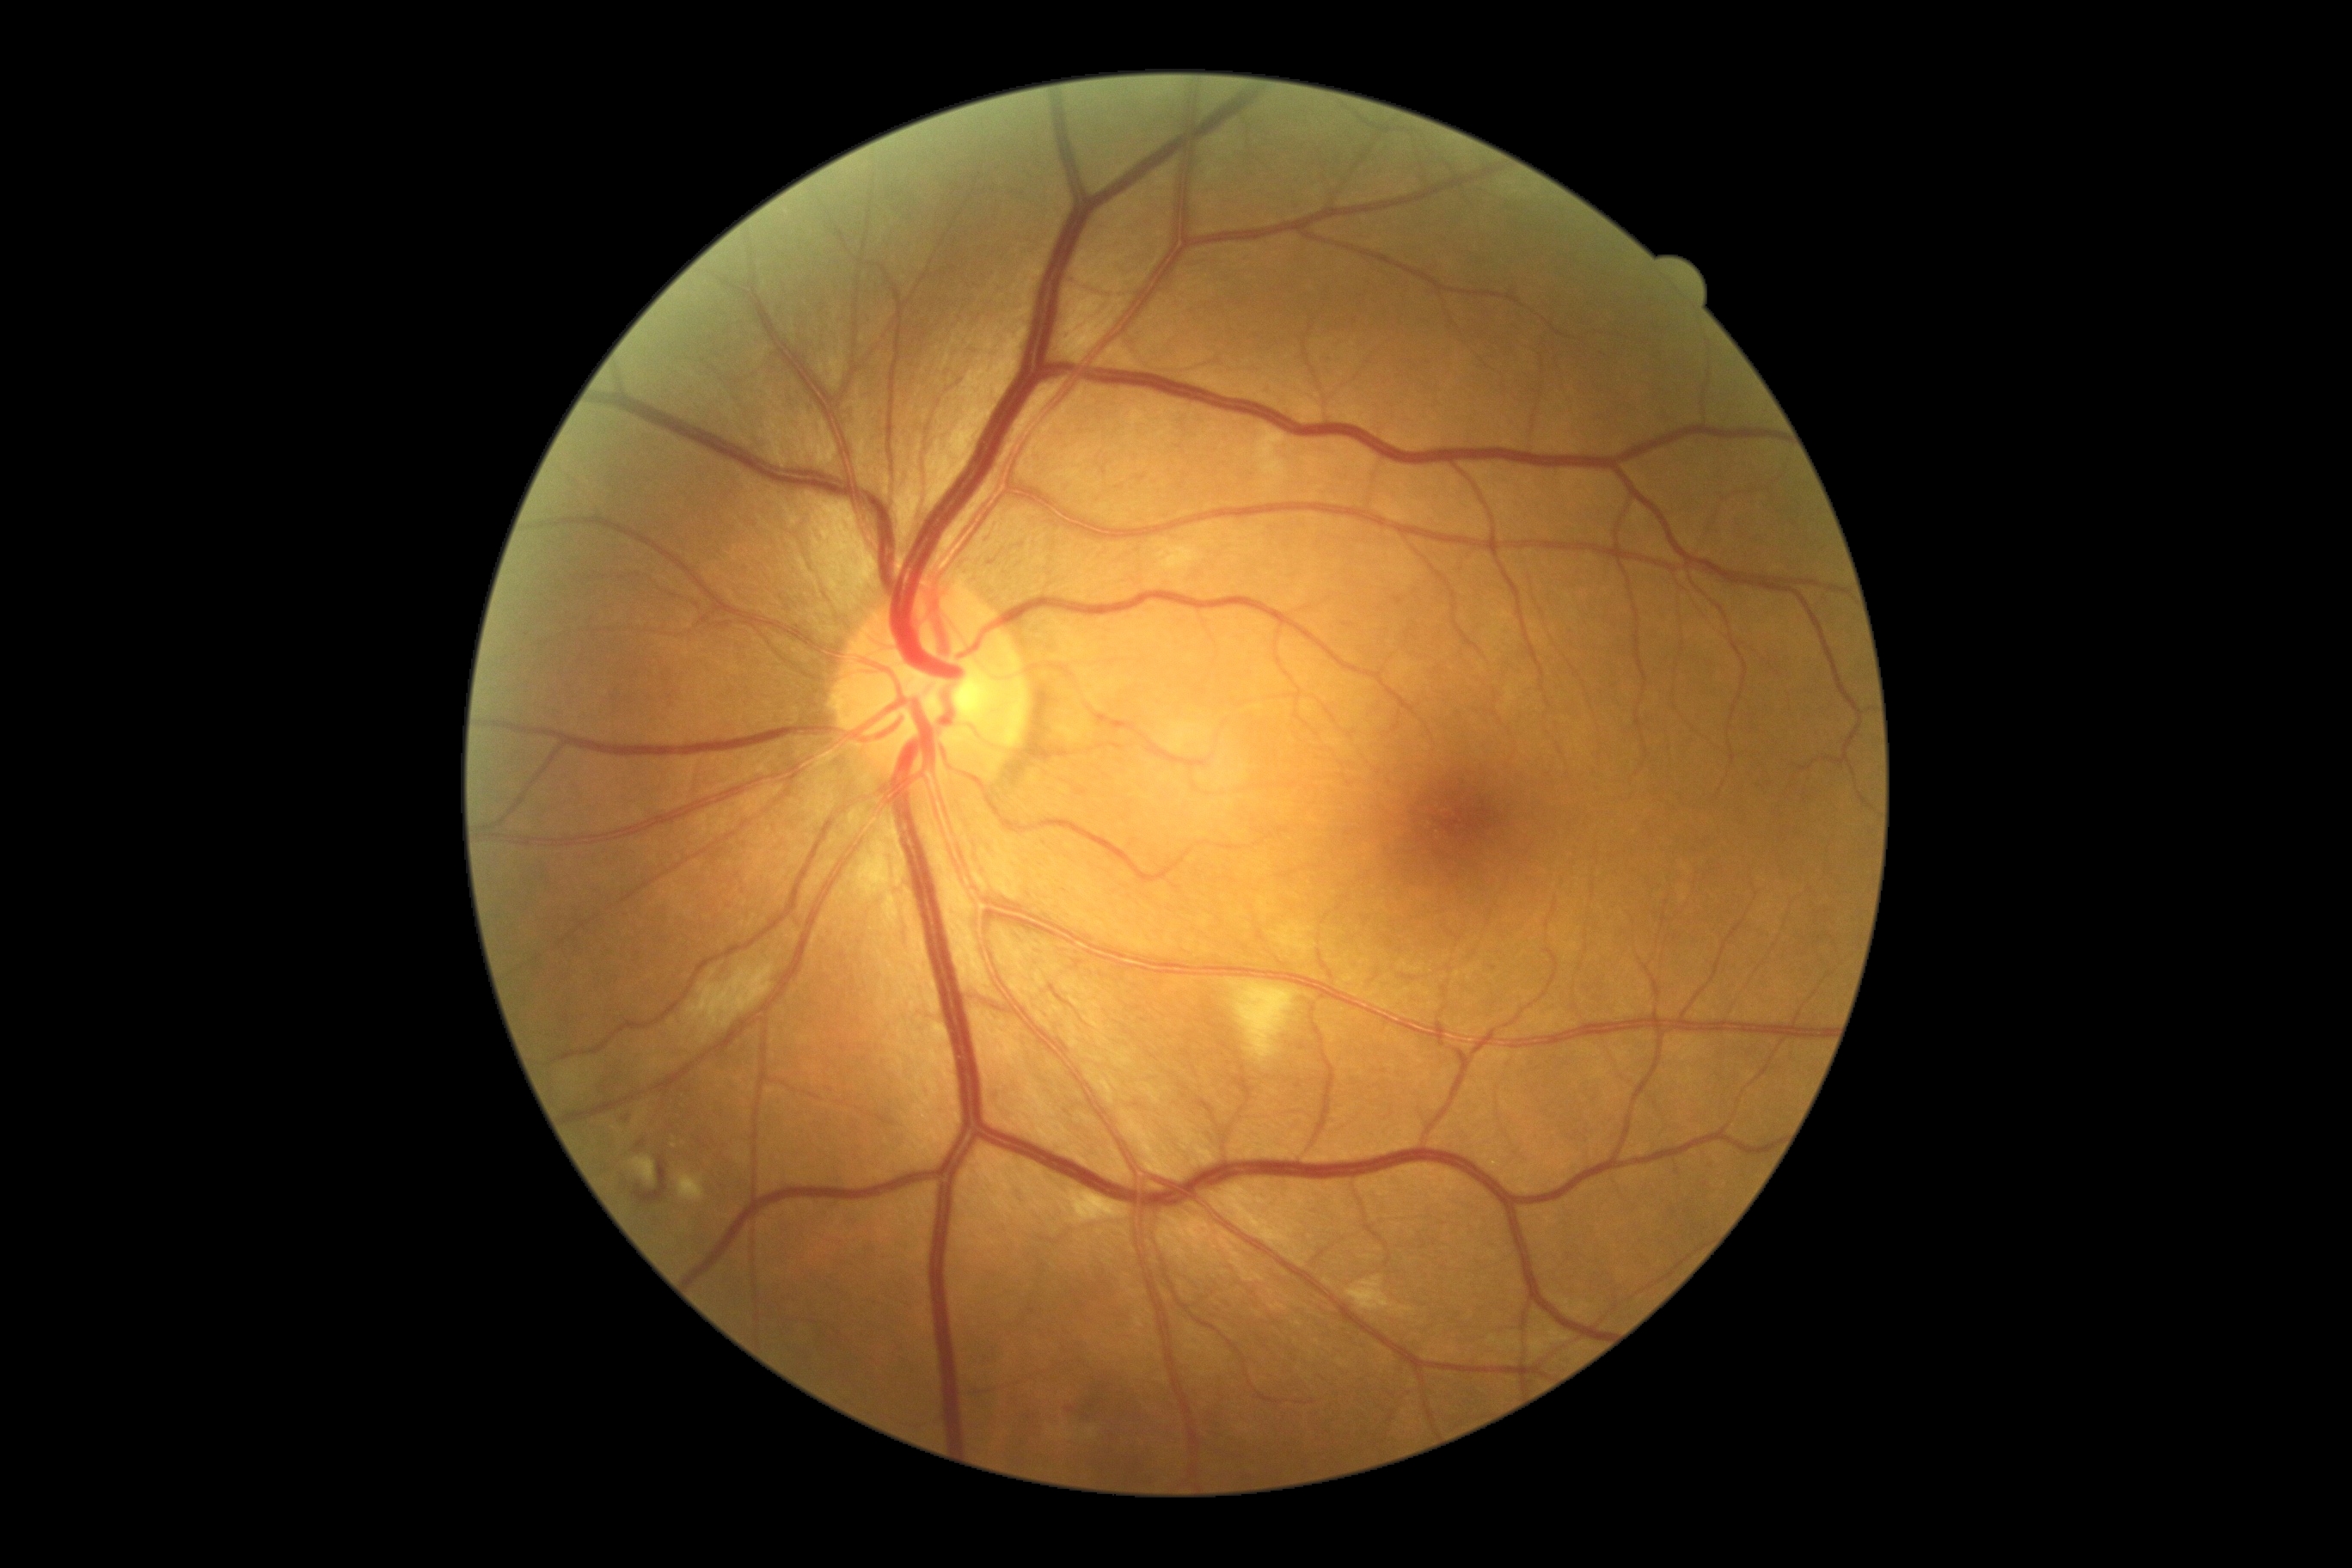
Findings:
* diabetic retinopathy (DR): grade 2 (moderate NPDR)